Captured on a Remidio FOP fundus camera. Color fundus image: 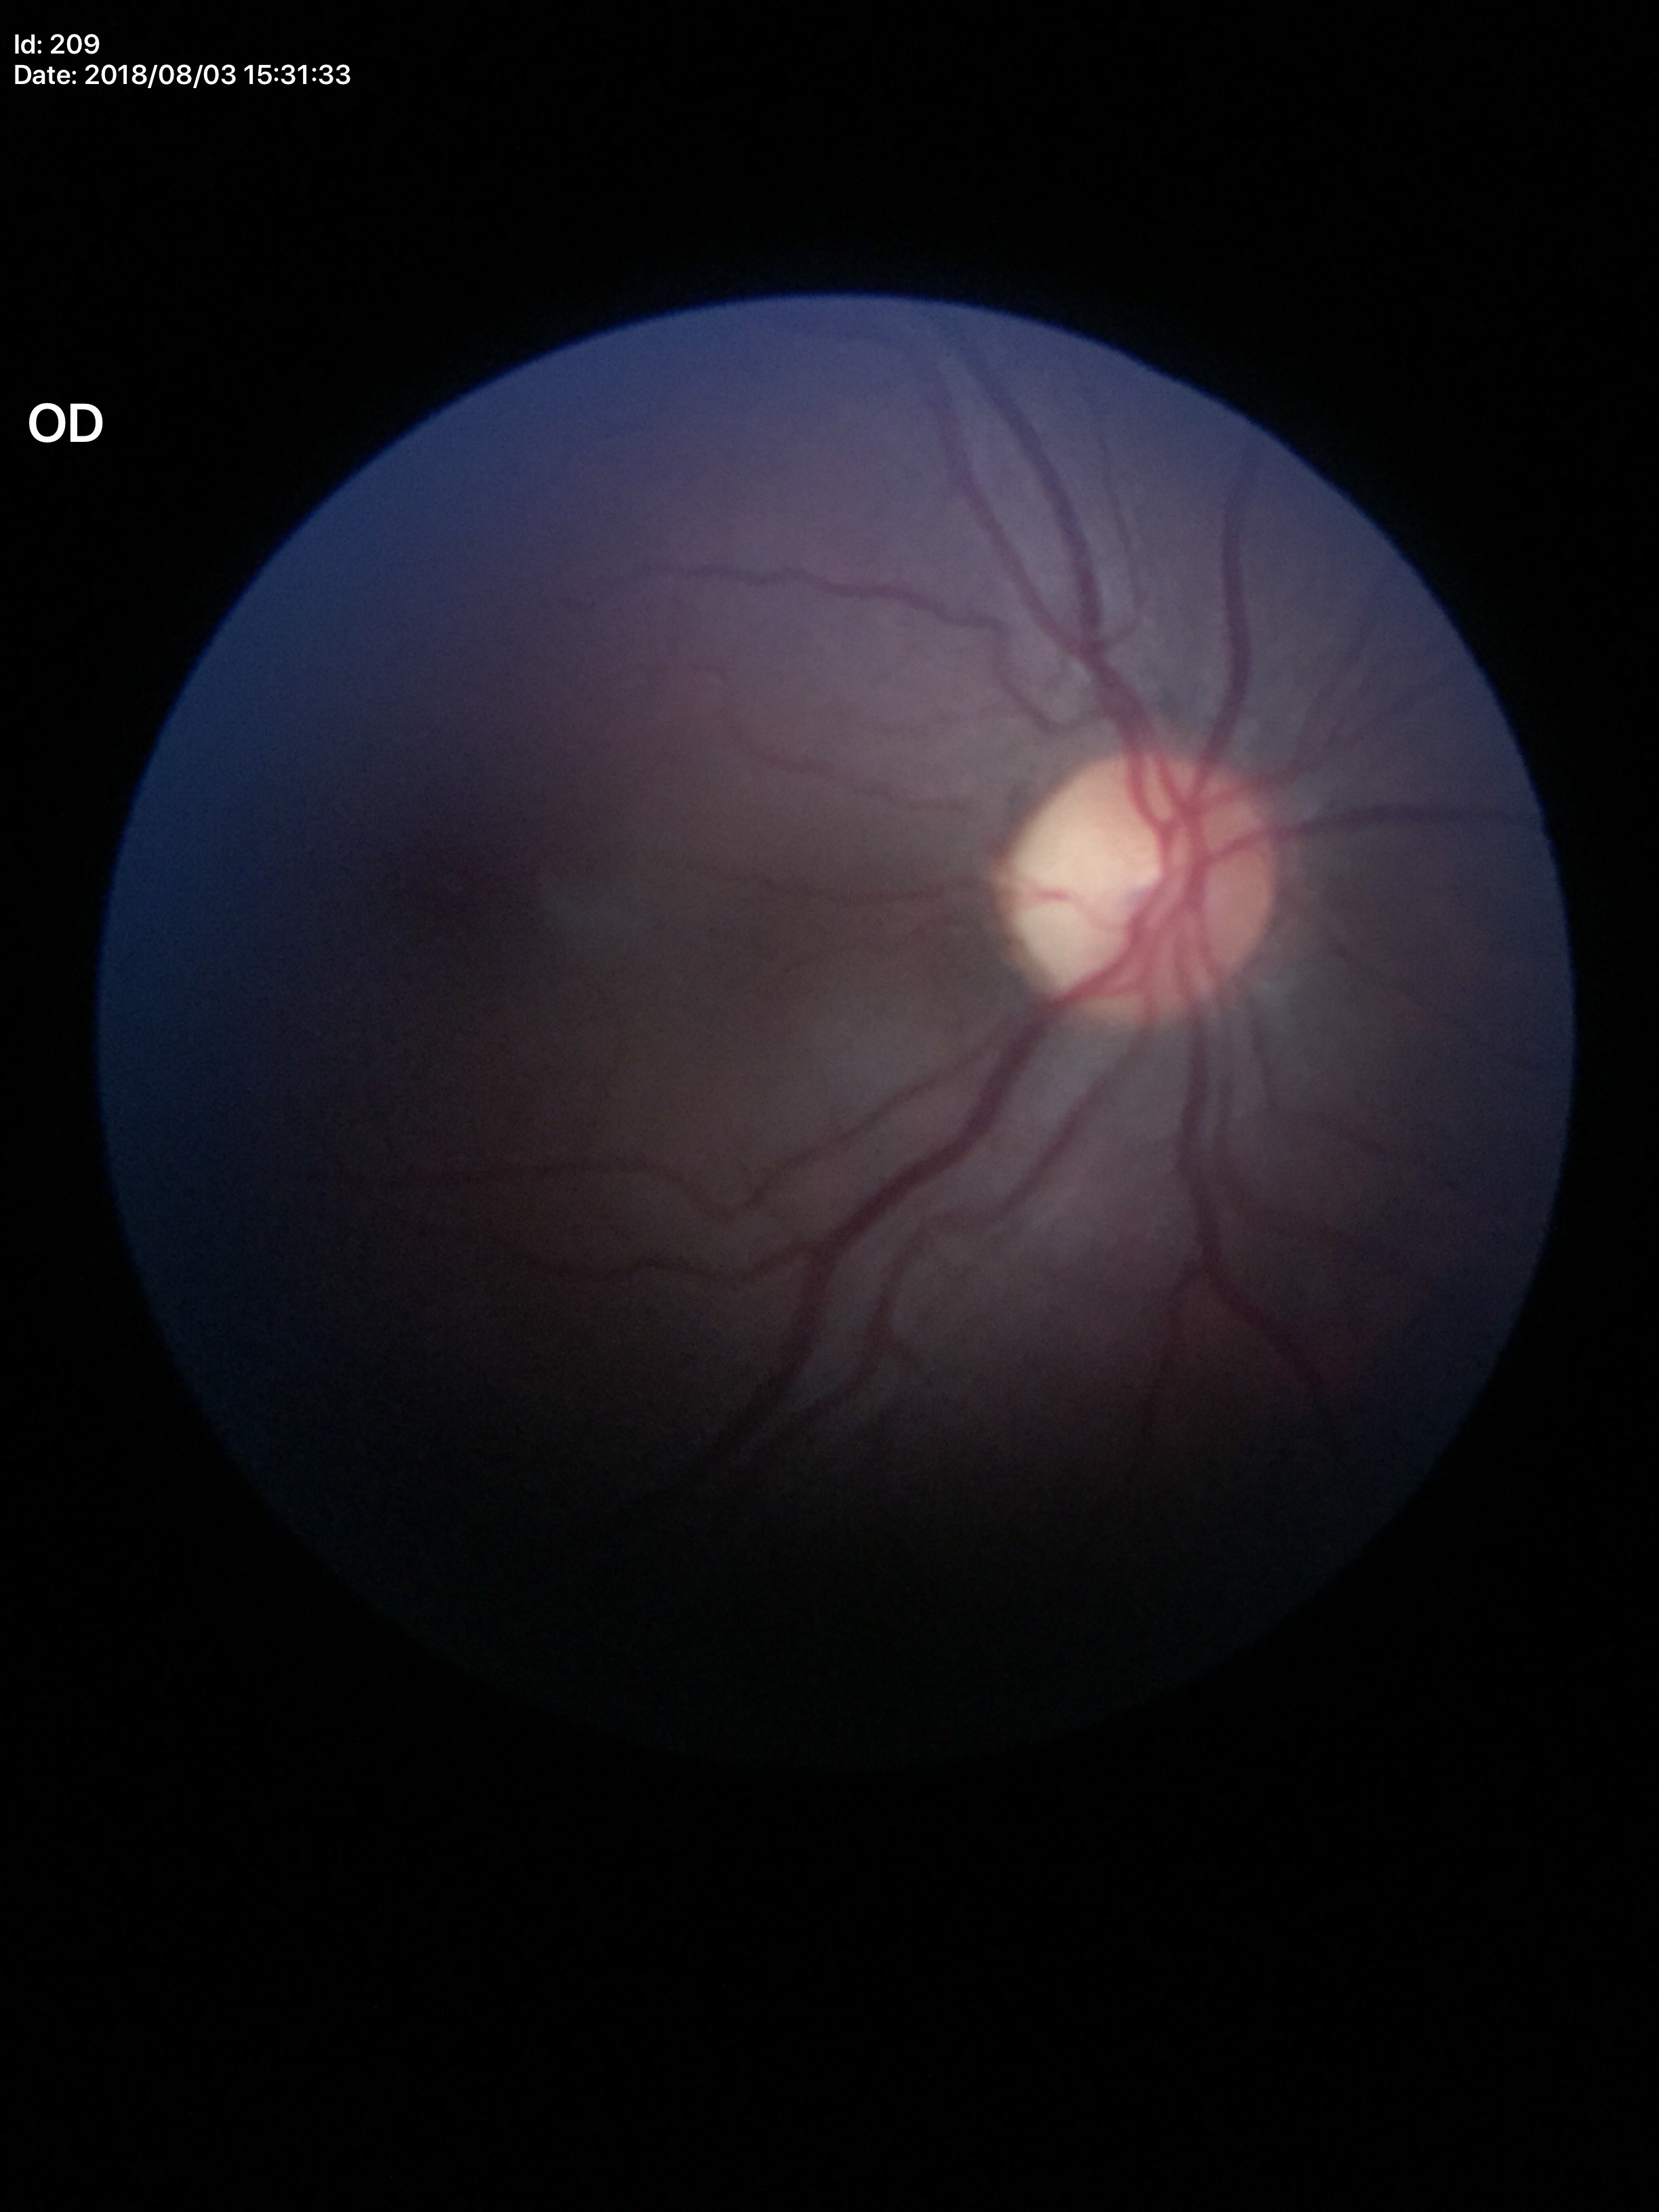

ACDR: 0.24
Glaucoma evaluation: not suspect
VCDR: 0.48